Captured on a Nidek AFC-330 fundus camera:
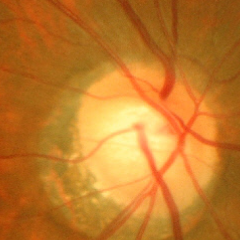
Early glaucomatous optic neuropathy.
Diagnostic criteria: glaucomatous retinal nerve fiber layer defects on red-free fundus photography without visual field defects.